NIDEK AFC-230, FOV: 45 degrees, nonmydriatic fundus photograph
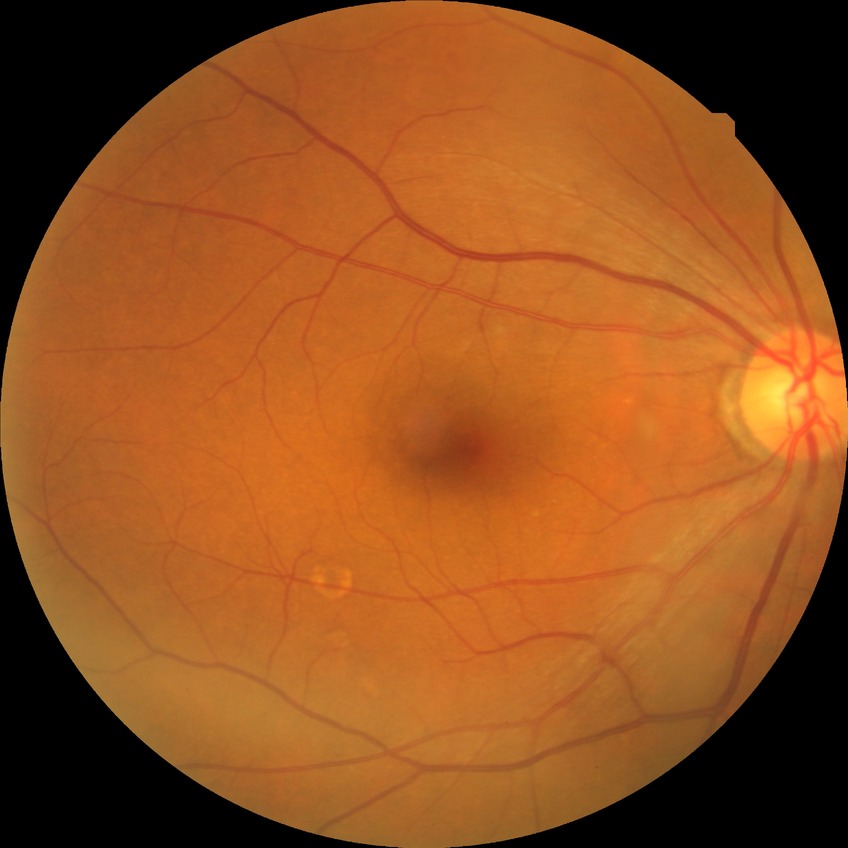 Retinopathy stage: no diabetic retinopathy.